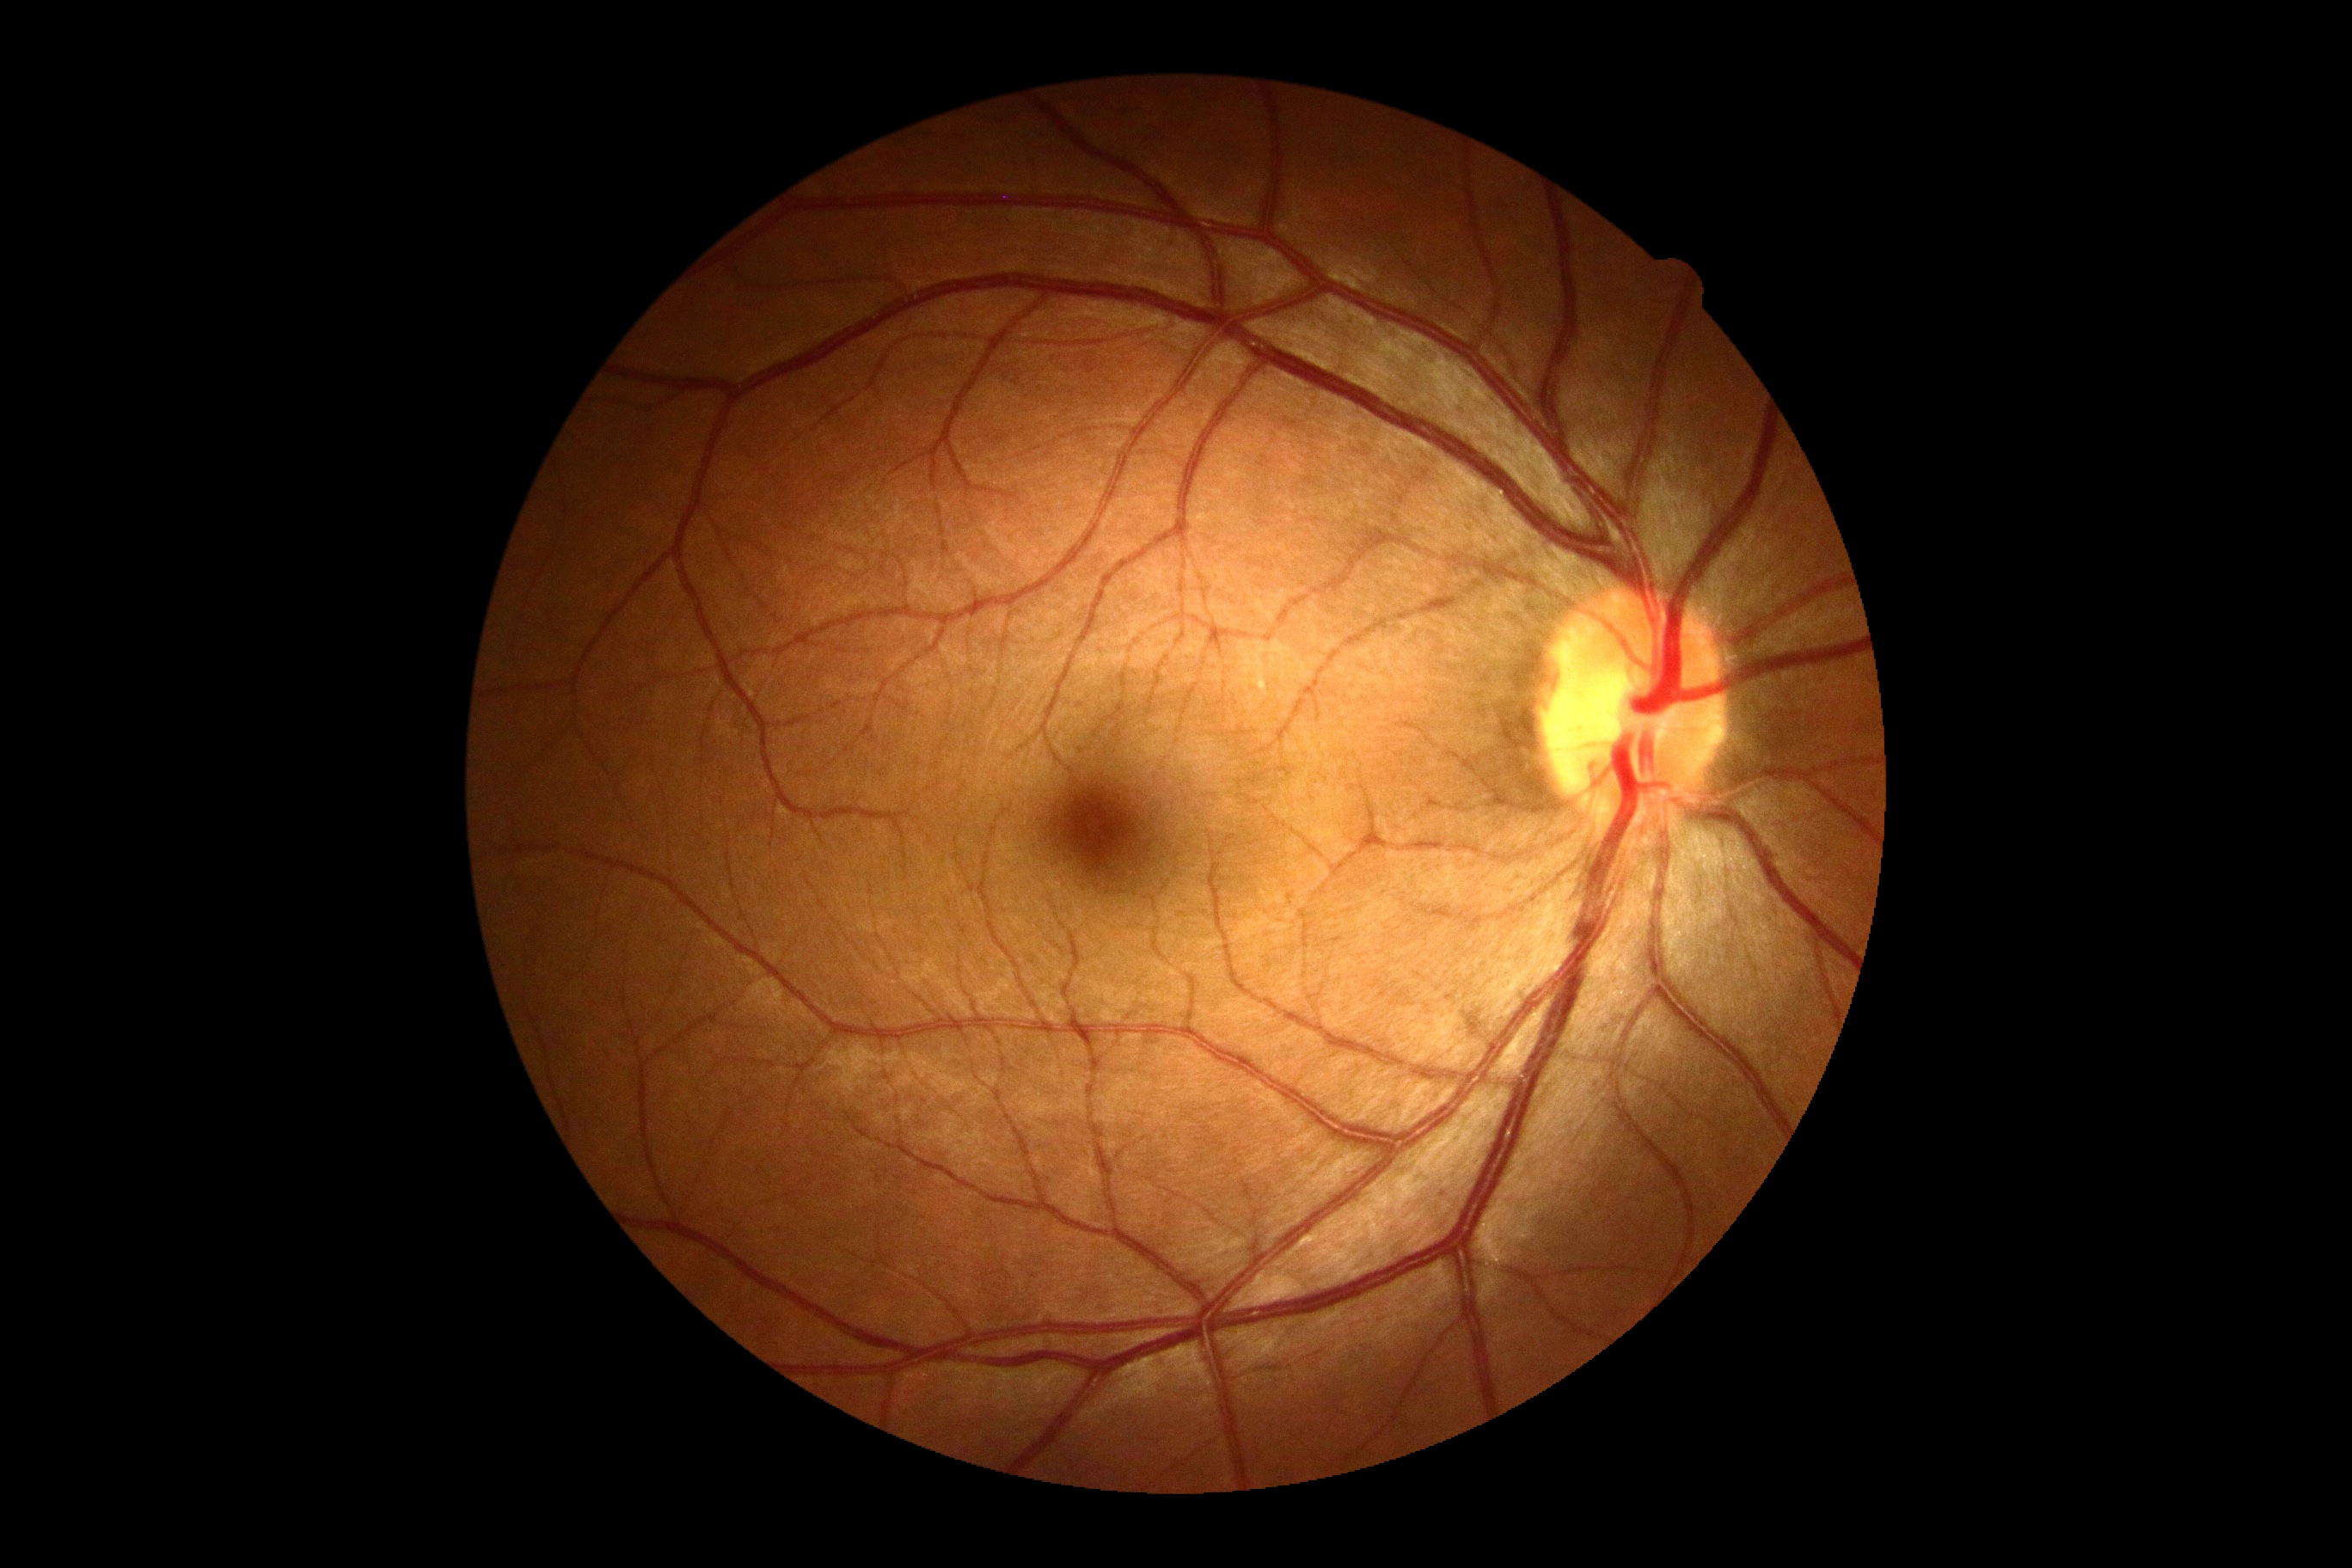 No apparent diabetic retinopathy. Diabetic retinopathy grade is no apparent retinopathy (0).